Wide-field fundus photograph from neonatal ROP screening; camera: Phoenix ICON (100° FOV); 1240 by 1240 pixels.
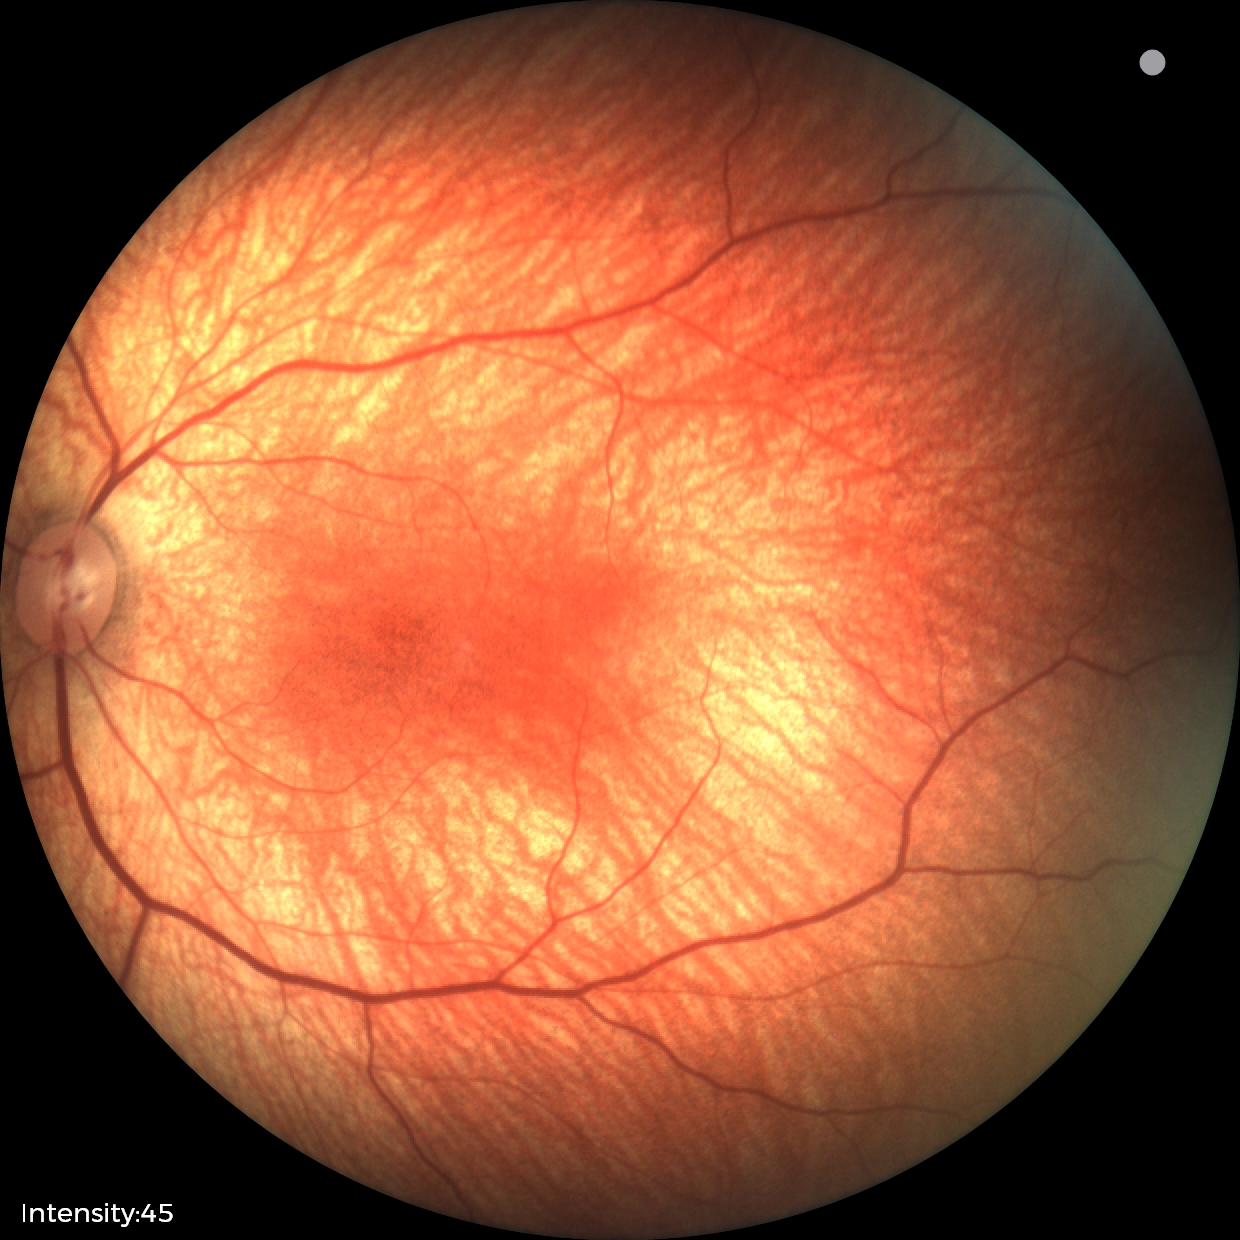

Impression = physiological appearance.